CFP
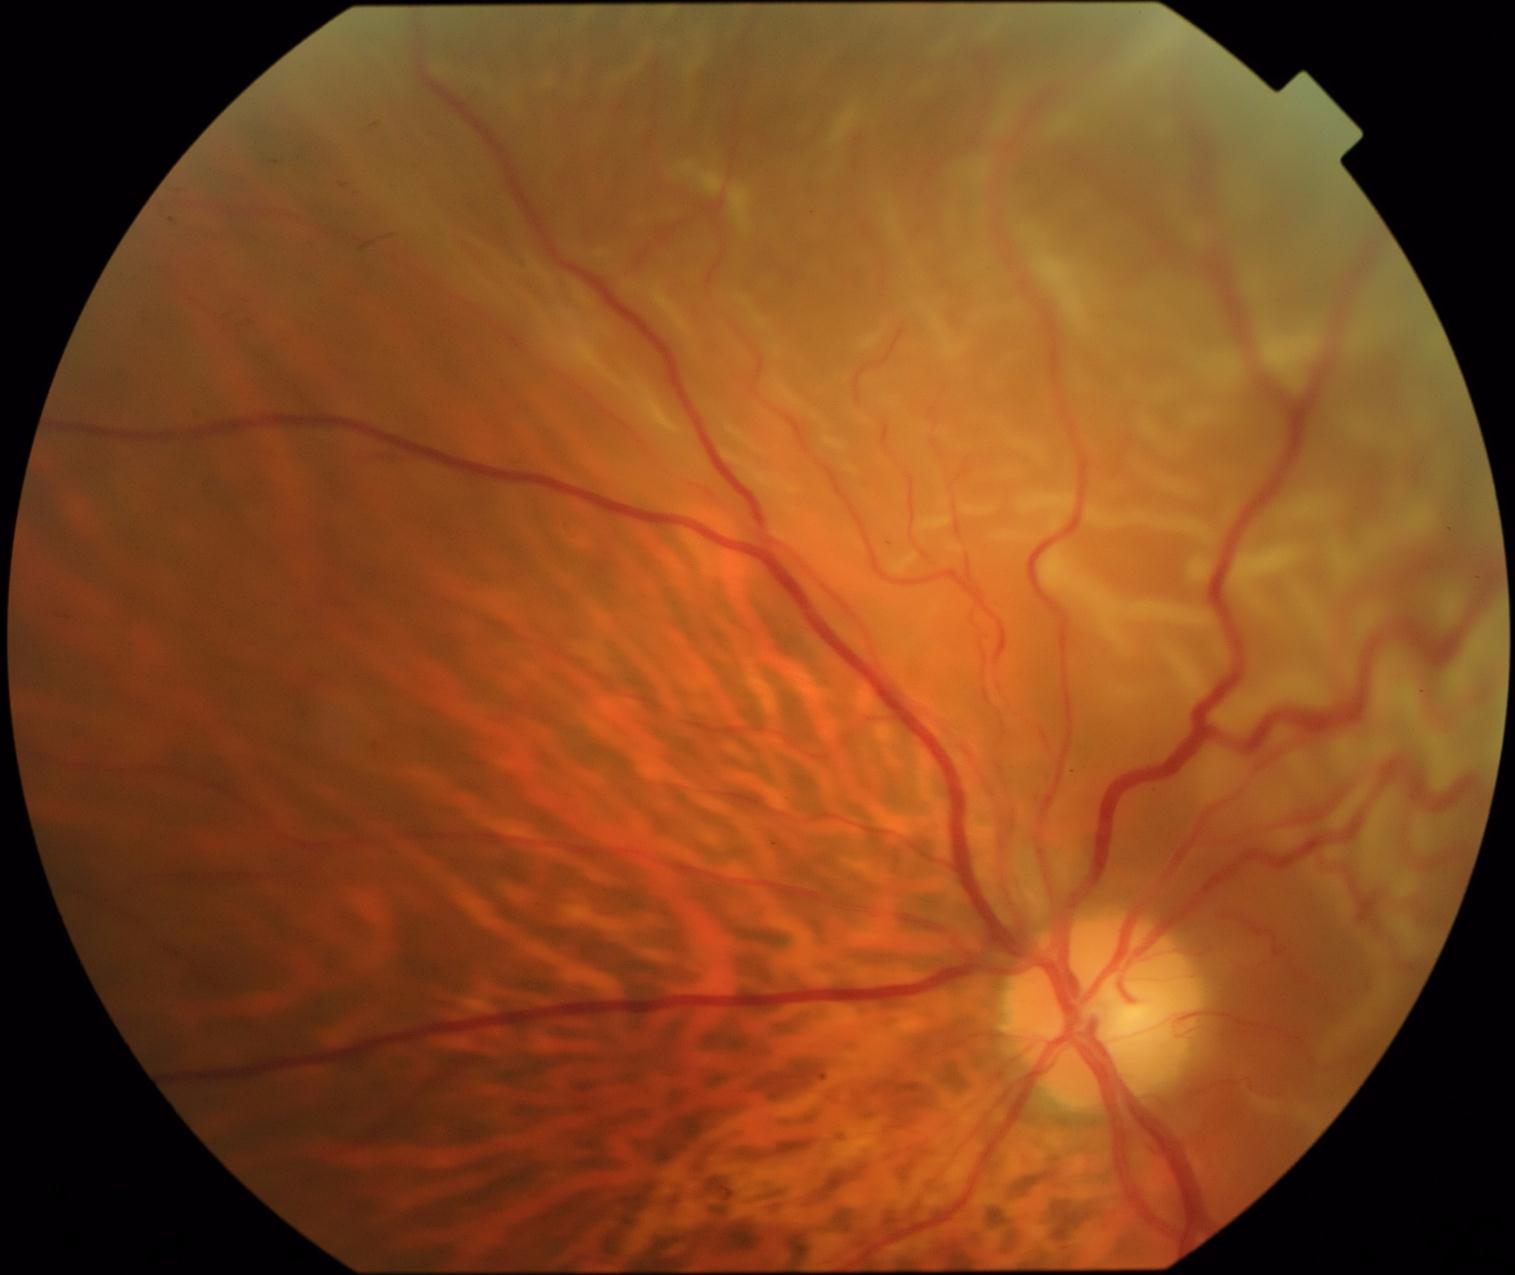
Diabetic retinopathy (DR) is grade 4 — neovascularization and/or vitreous/pre-retinal hemorrhage.